Color fundus photograph:
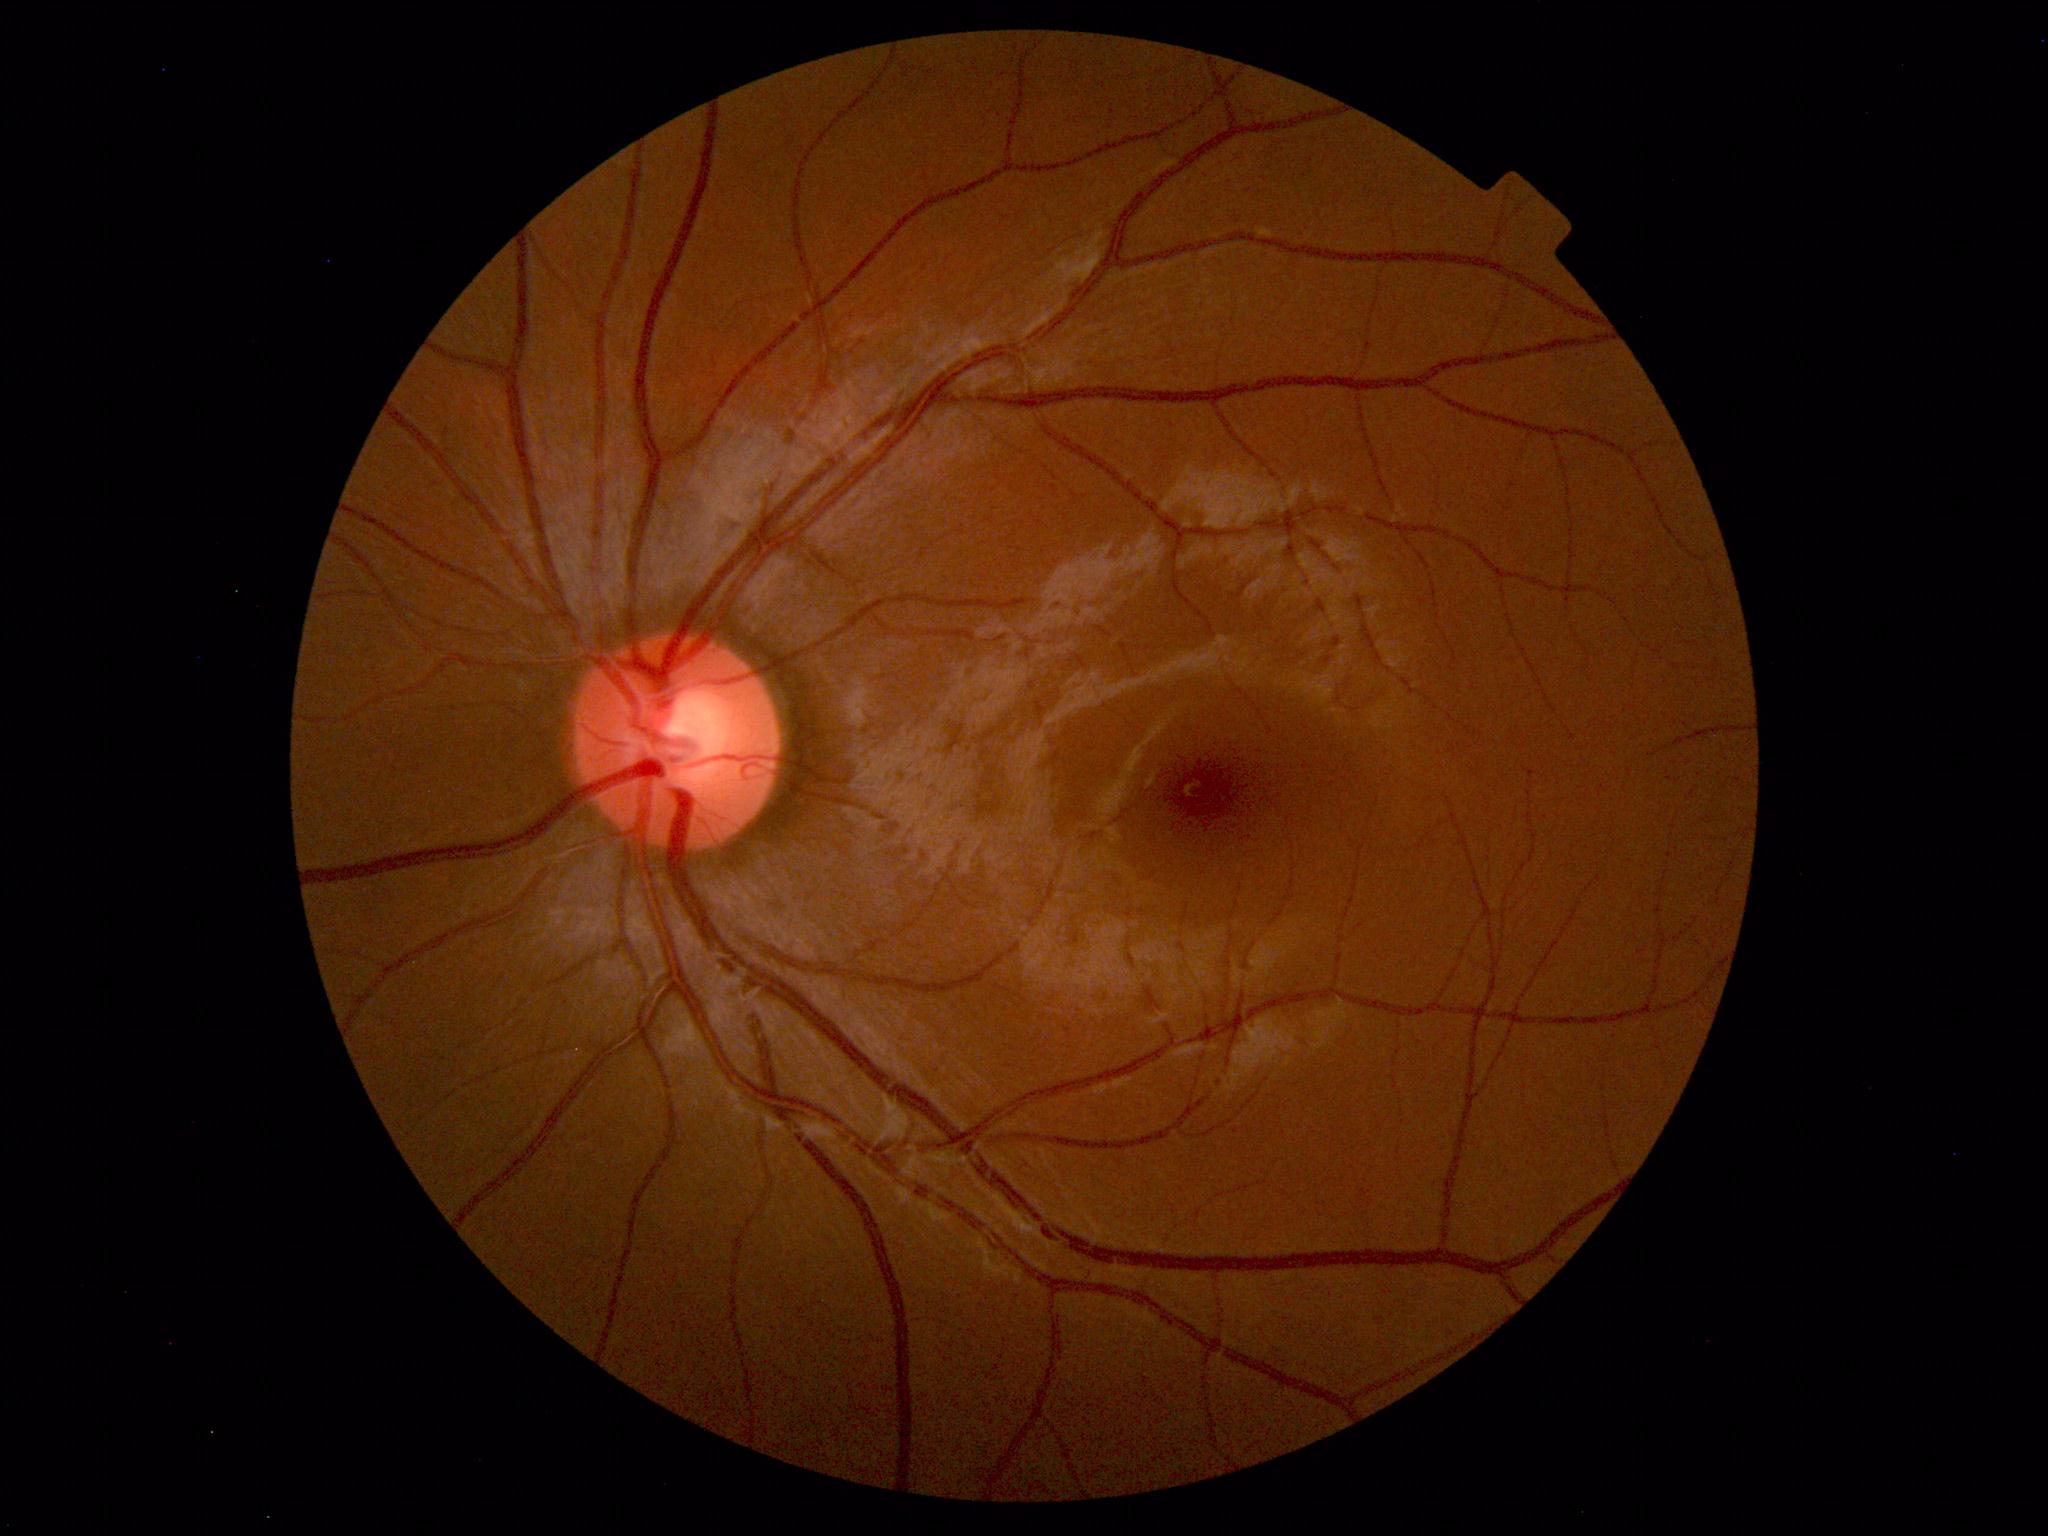 Within normal limits. No abnormalities identified.